Non-mydriatic acquisition, 240x240px, color fundus photograph — 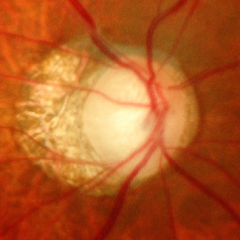

Diagnosis = advanced glaucomatous optic neuropathy.